Color fundus photograph centered on the optic disc. Mydriatic acquisition: 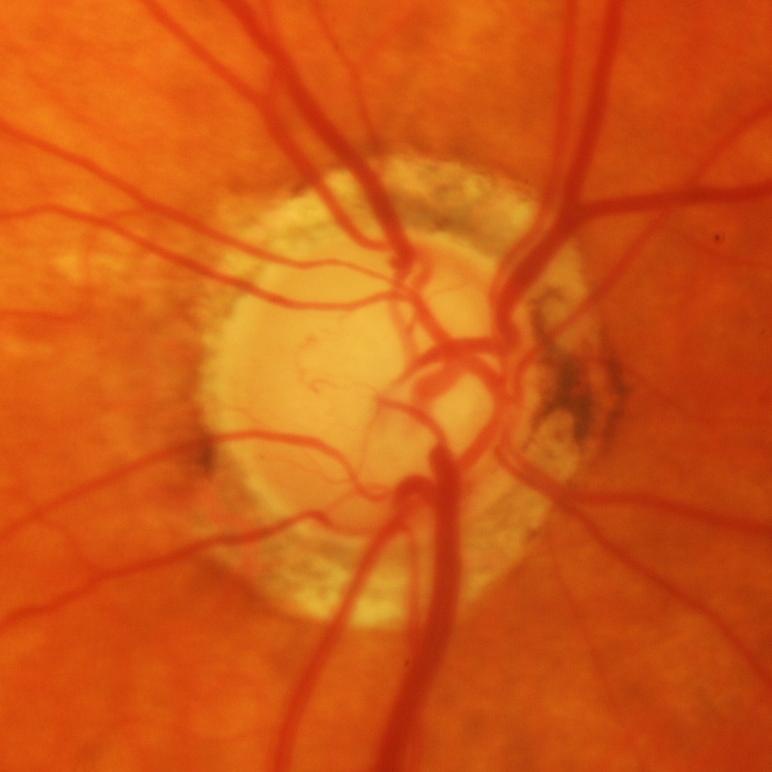
Q: What is the glaucoma diagnosis?
A: Yes — glaucomatous findings.